Color fundus photograph. 512x512px.
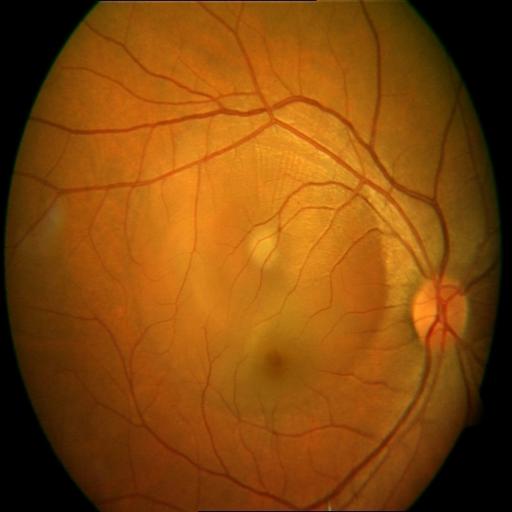 There is evidence of central serous retinopathy.